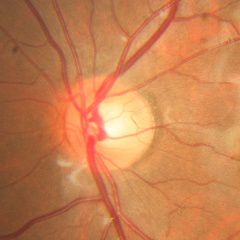
Optic nerve head appearance consistent with no glaucomatous optic neuropathy.